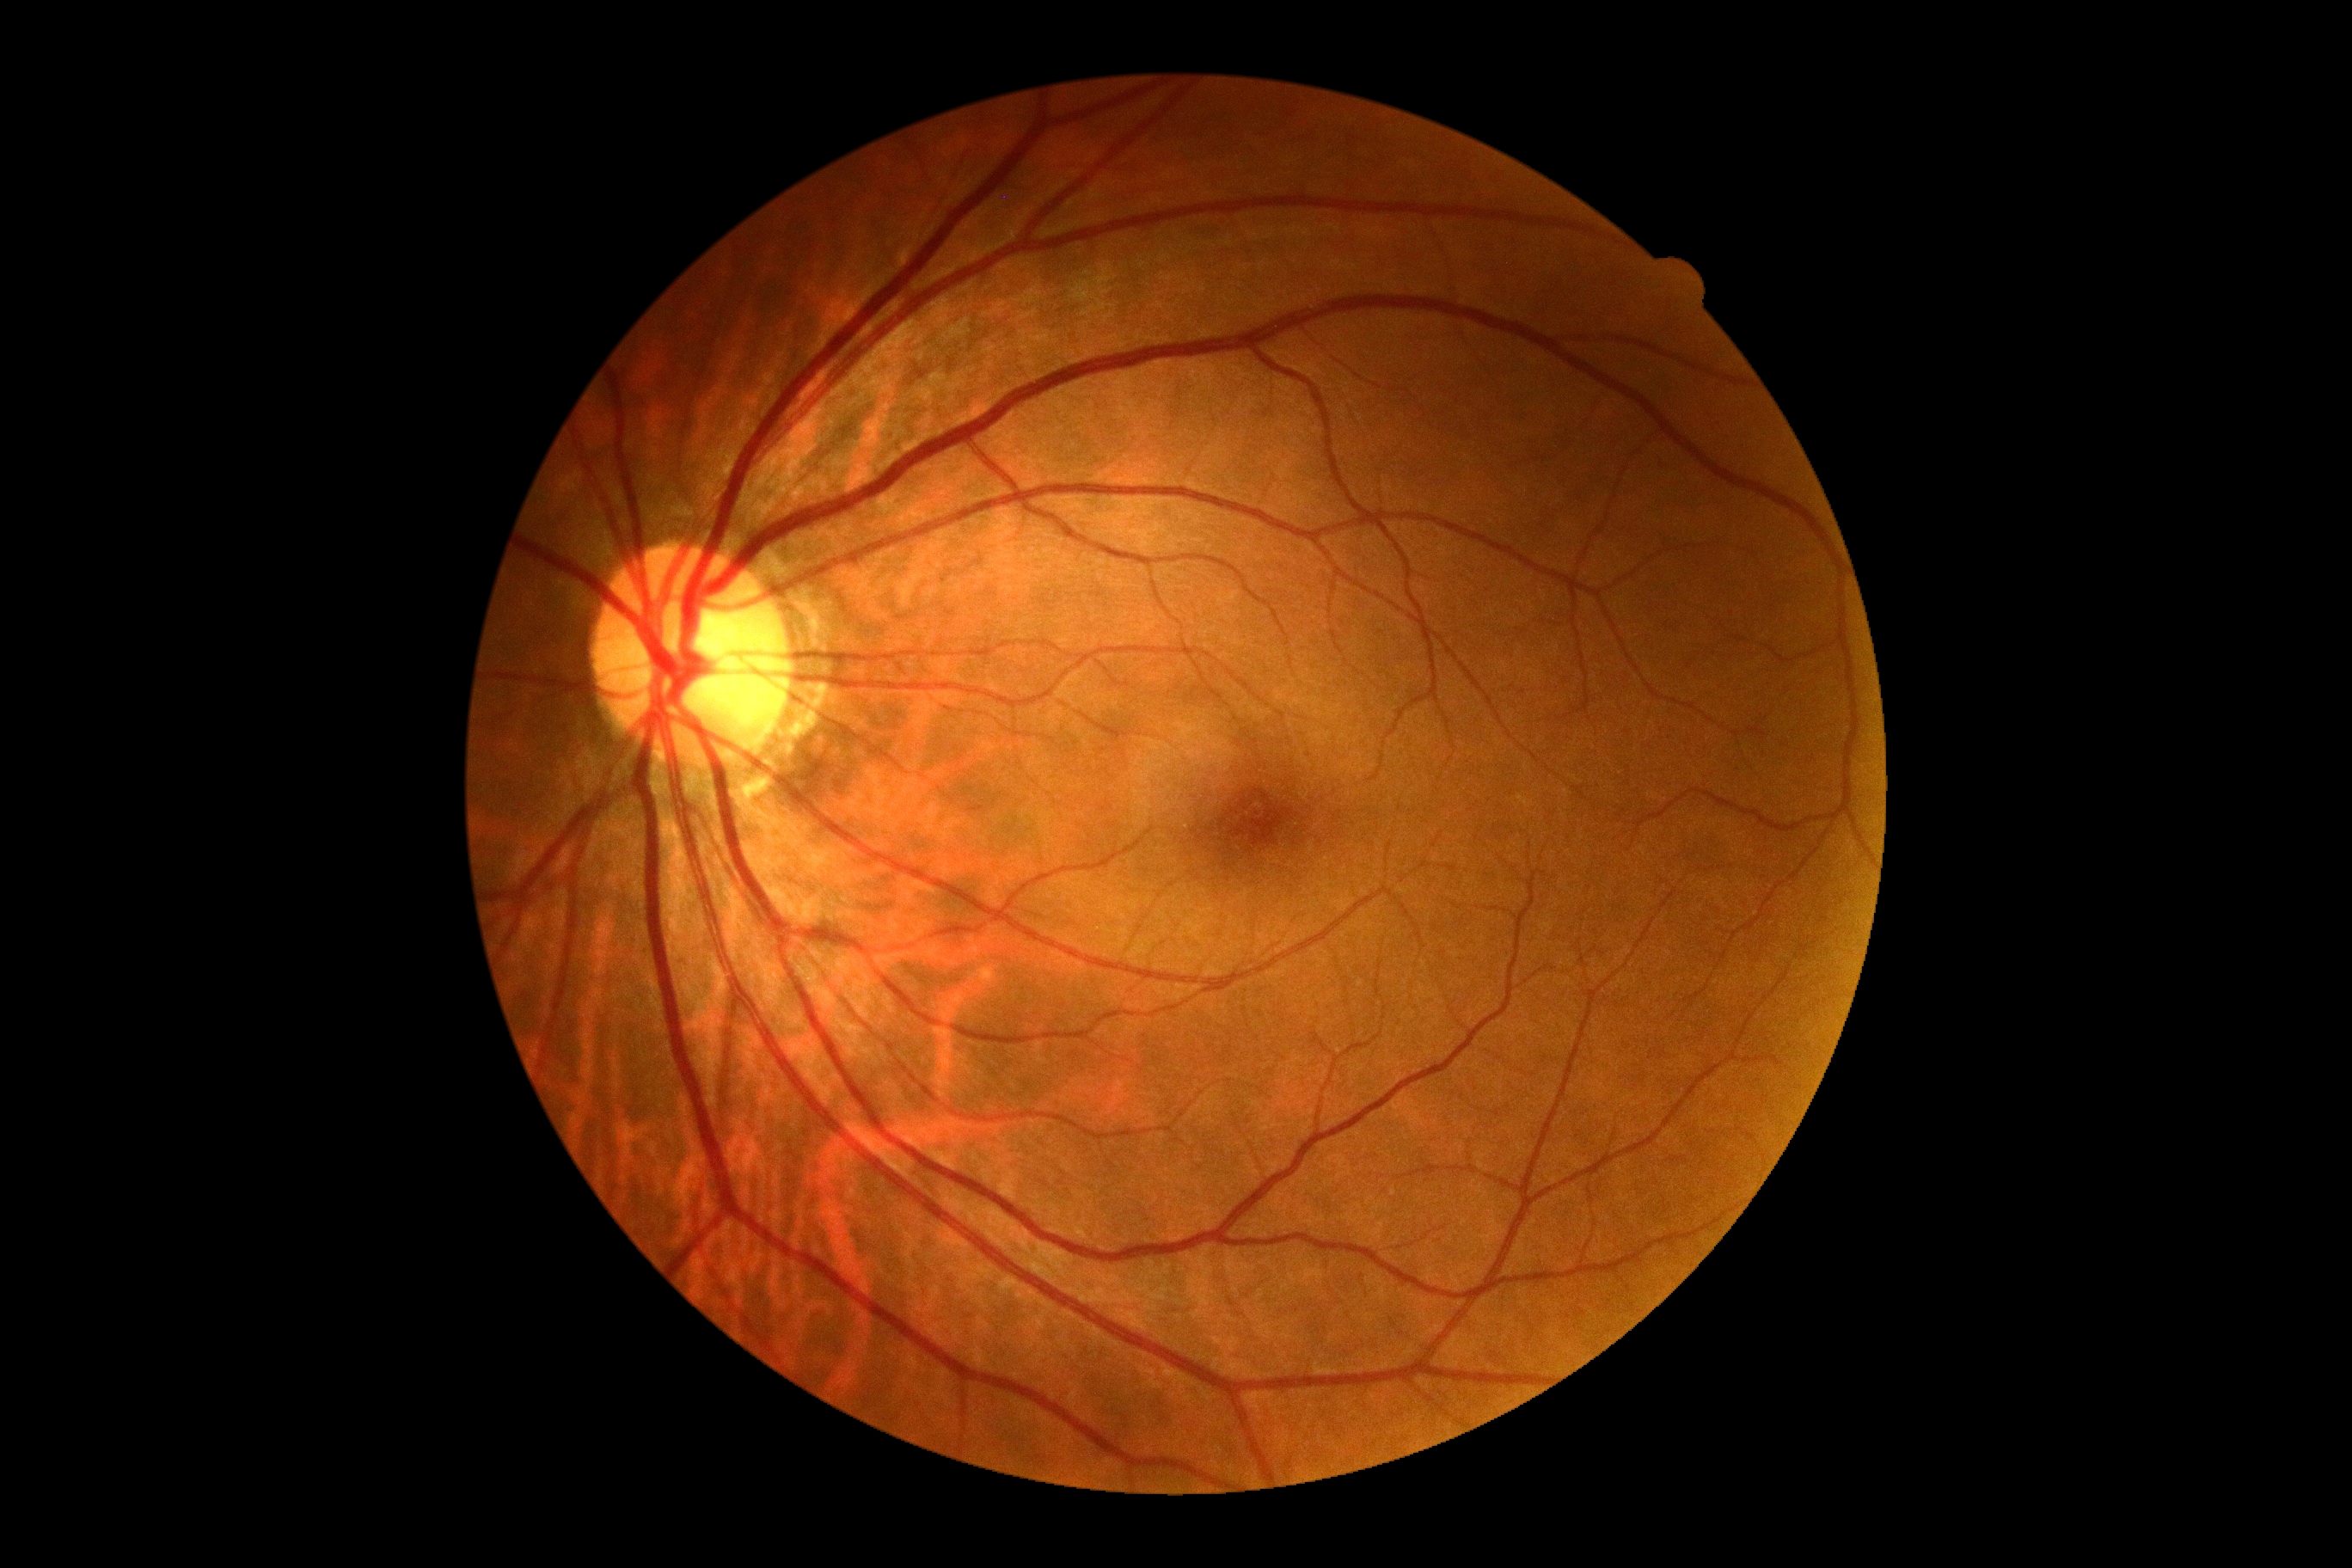
DR = grade 0 — no visible signs of diabetic retinopathy